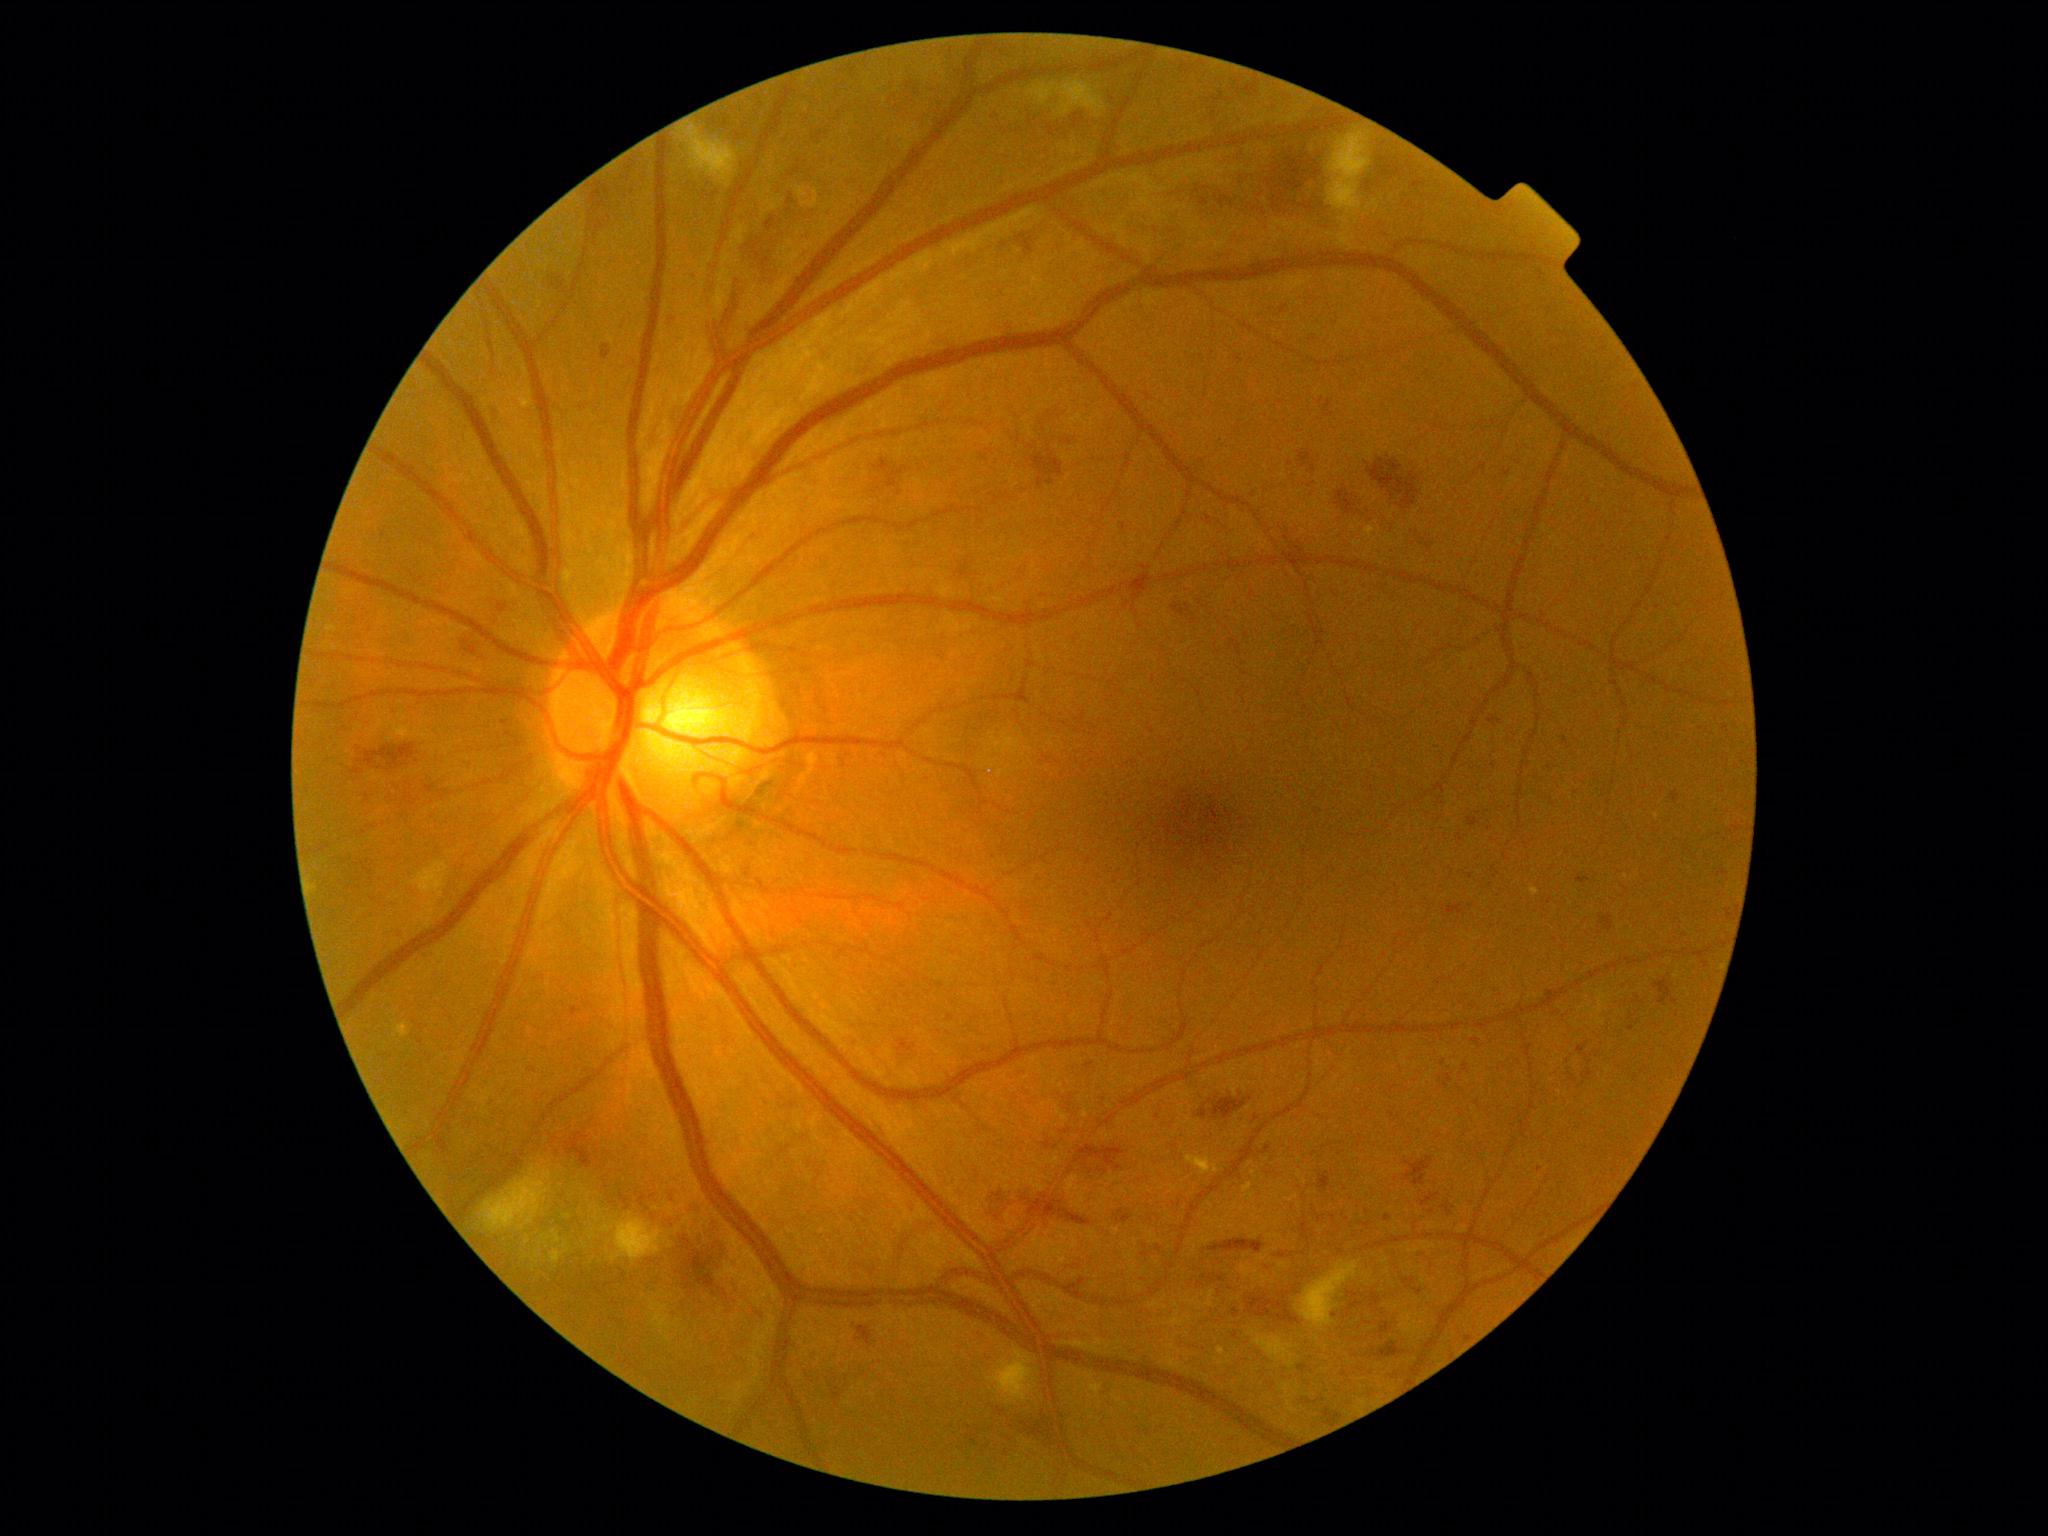 DR stage=moderate NPDR (grade 2).